Retinal fundus photograph.
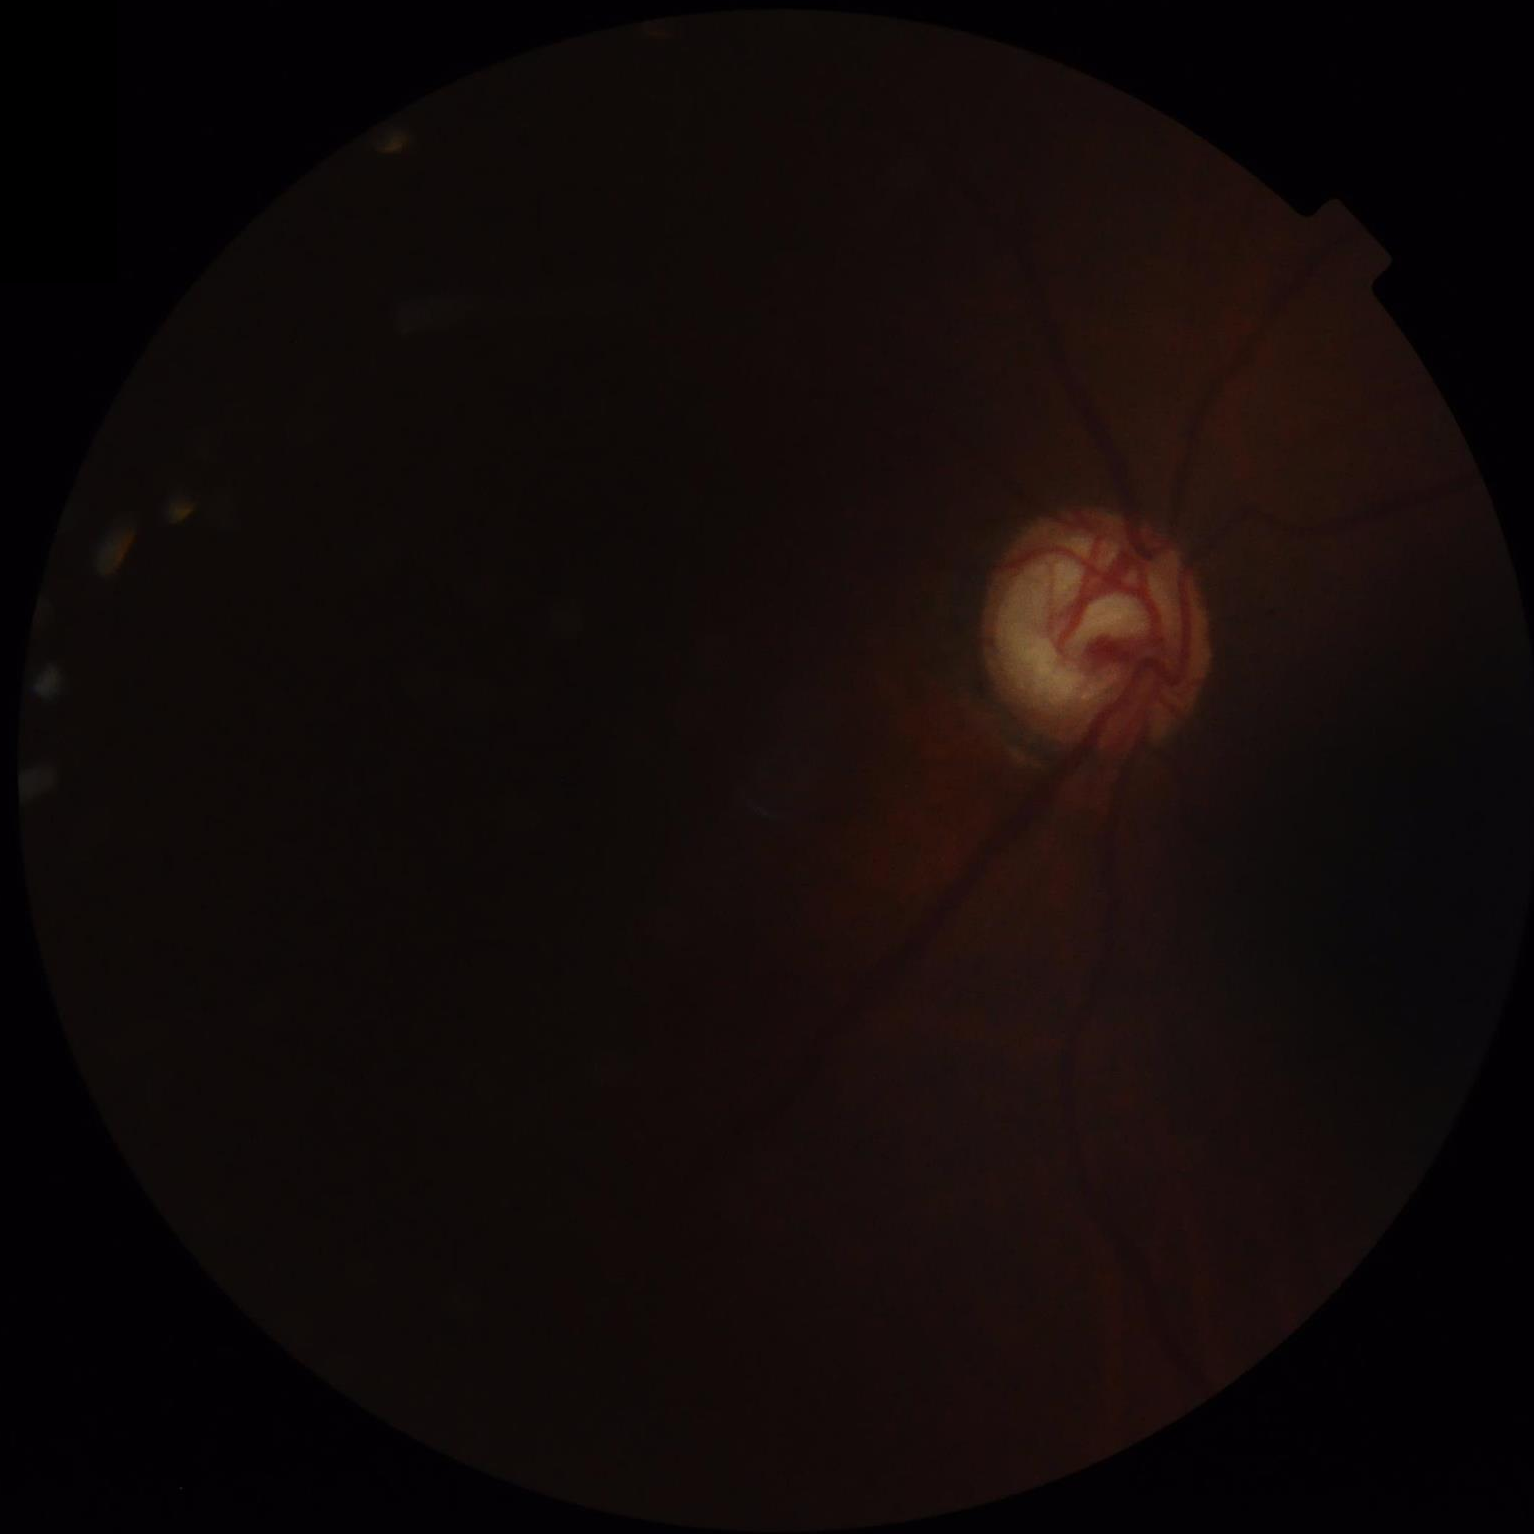
Image quality:
- focus: poor
- overall: inadequate
- contrast: reduced
- illumination: suboptimal